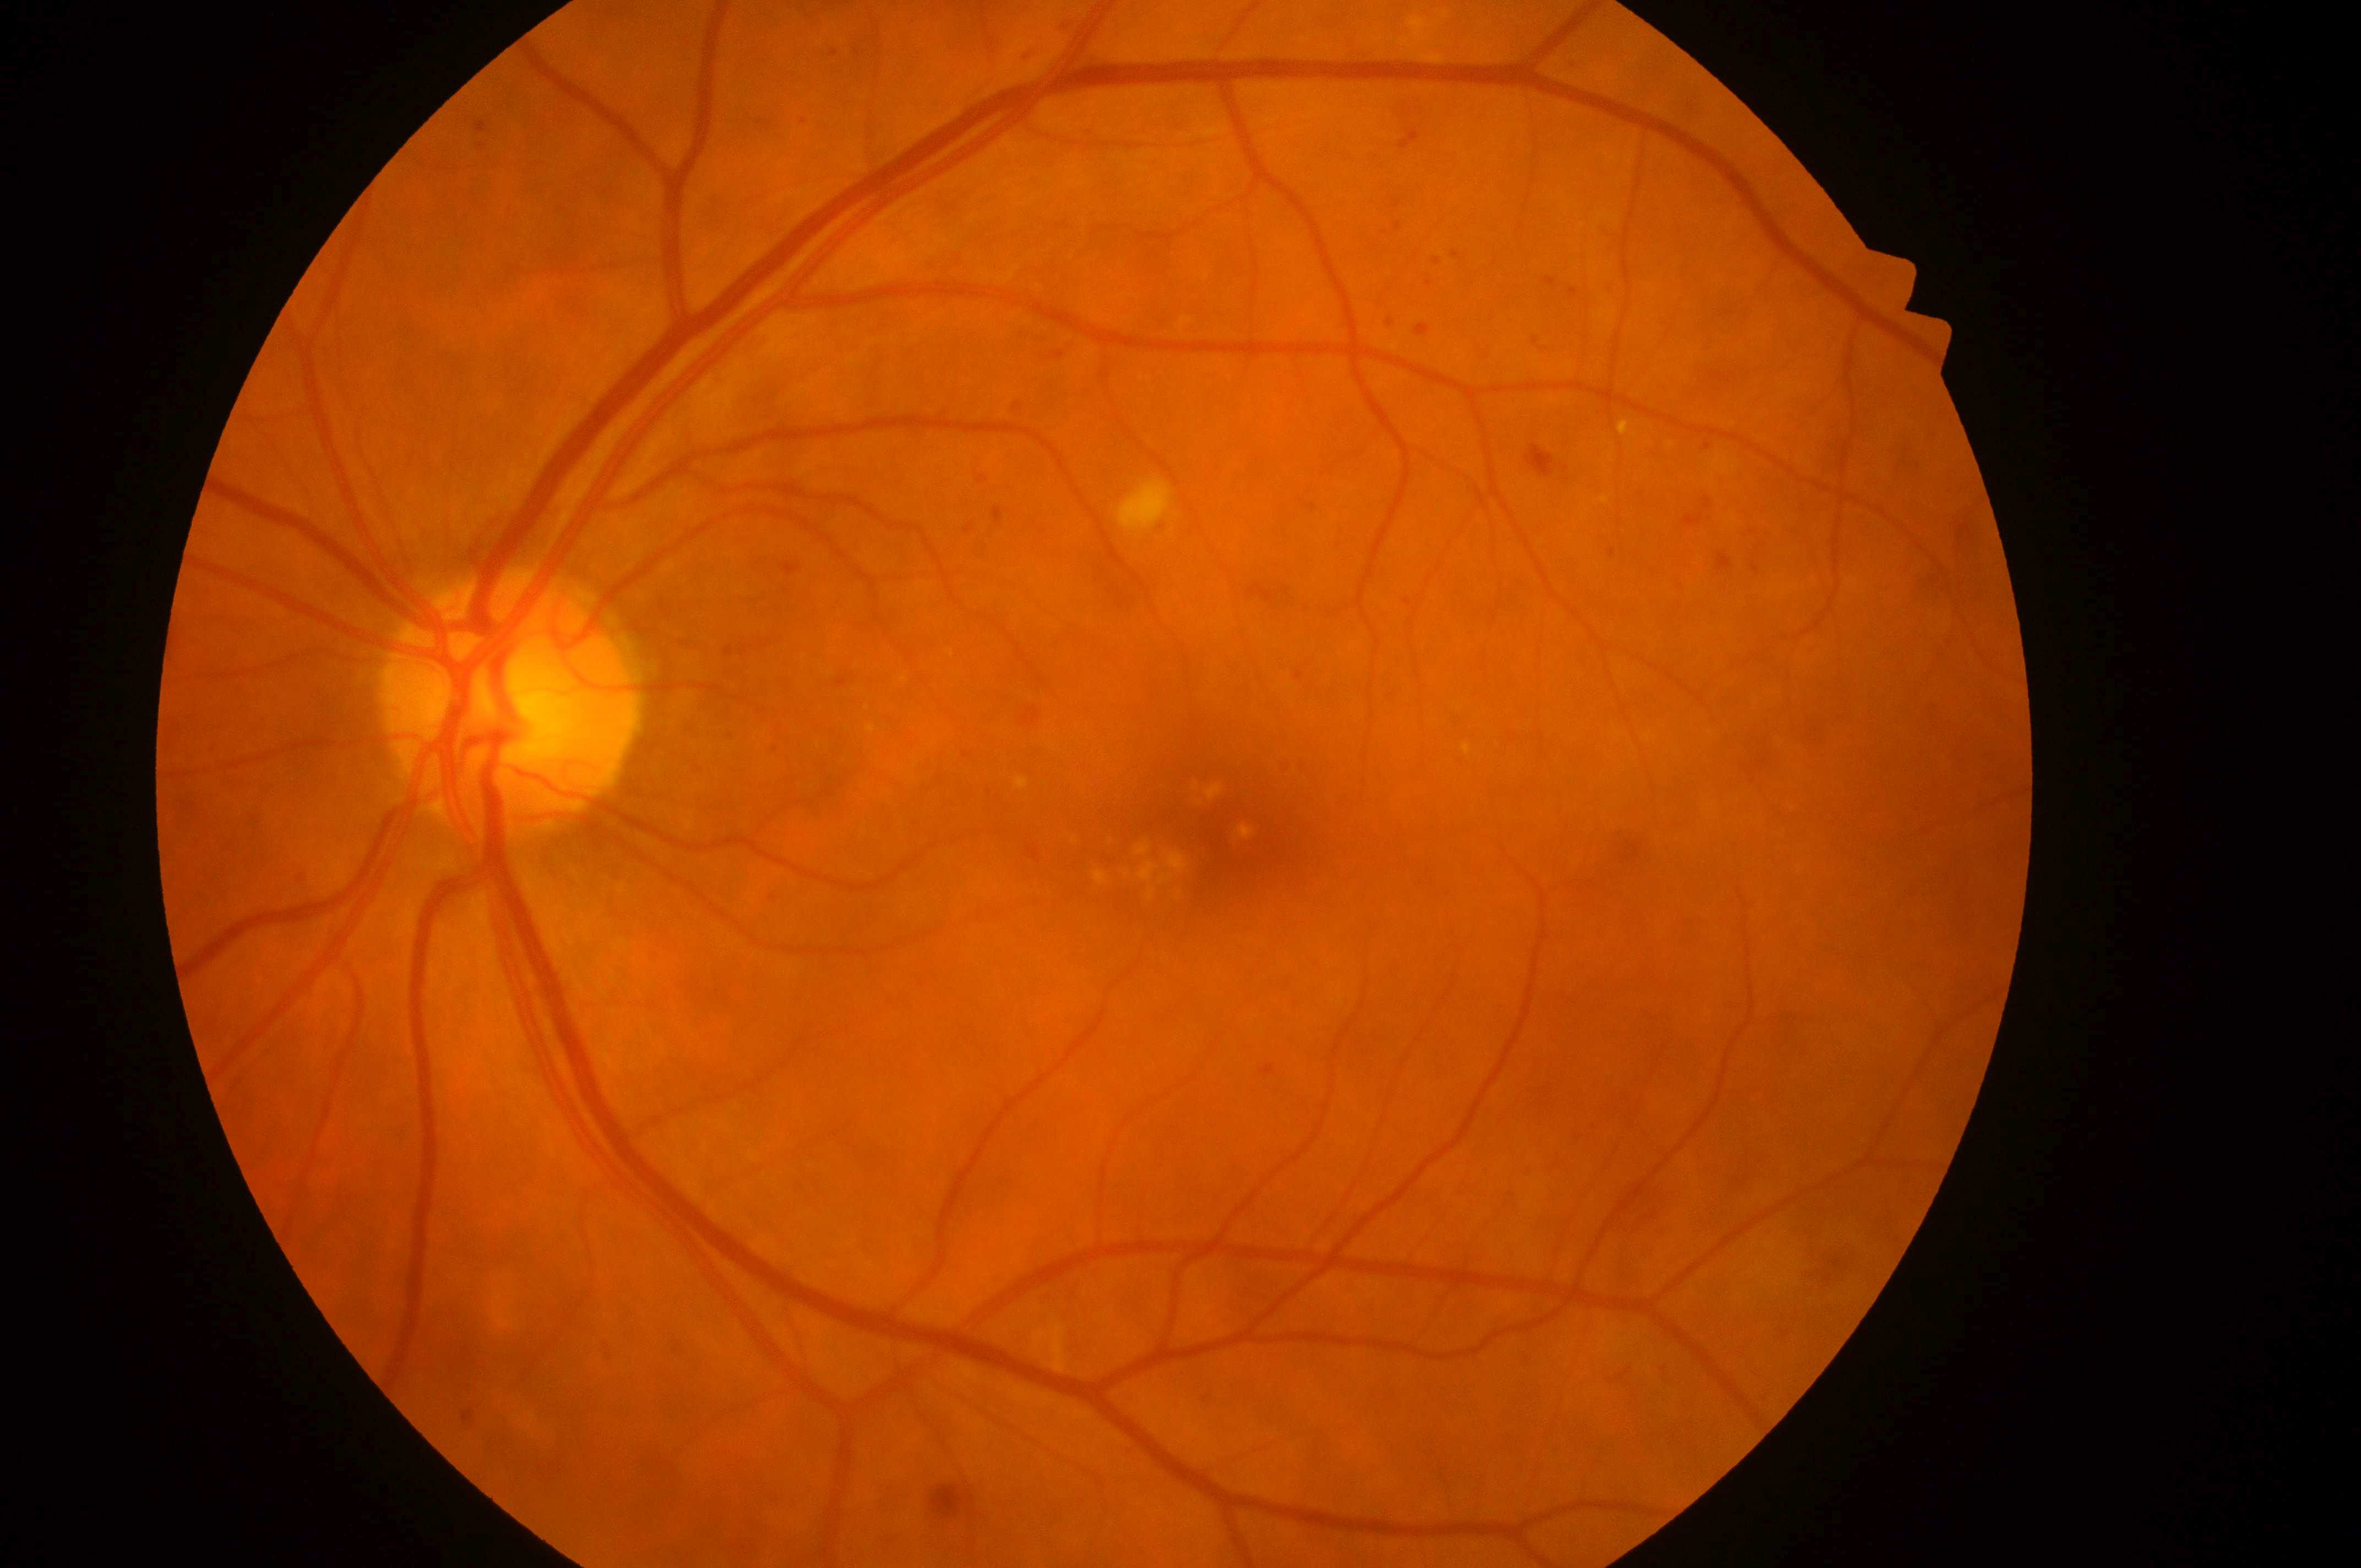
Macular edema risk is grade 2 (high risk). Optic disc center located at [501, 709]. Diabetic retinopathy grade is moderate NPDR (2). The retinopathy is classified as non-proliferative diabetic retinopathy. Foveal center: [1213, 835]. This is the oculus sinister.